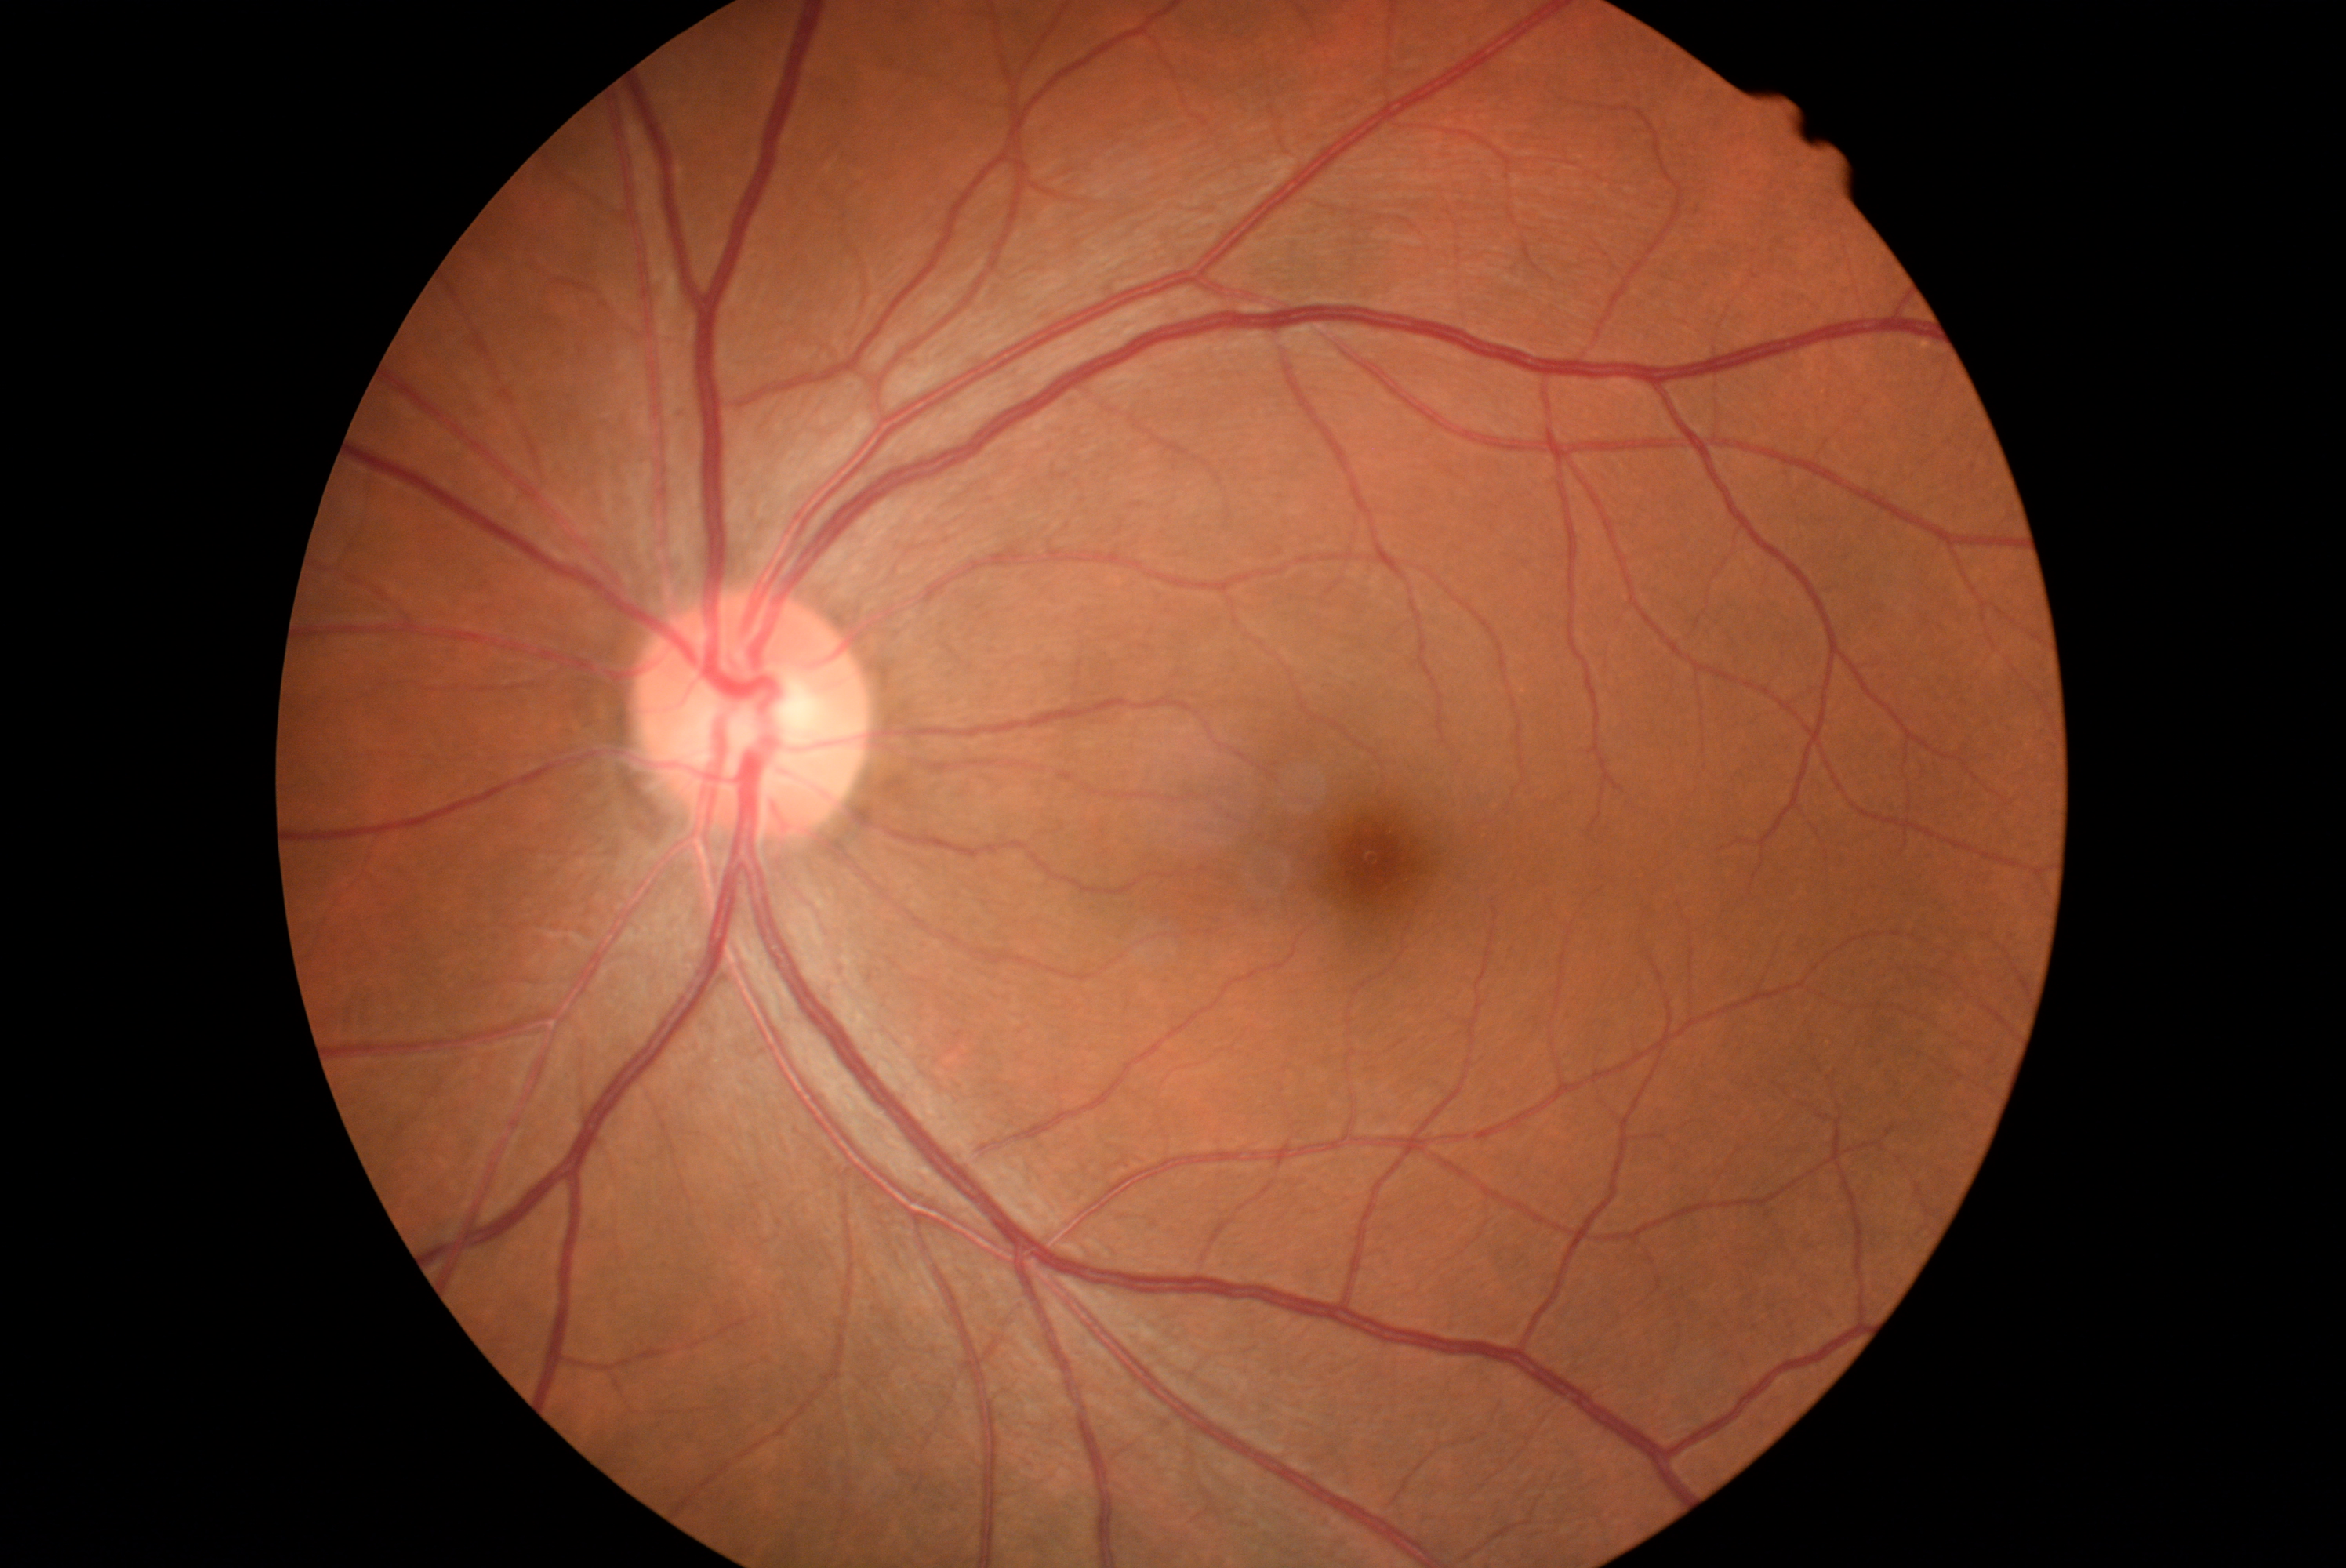
DR is no apparent retinopathy (grade 0).